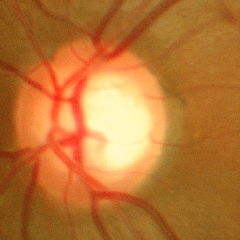 Optic nerve head appearance consistent with no evidence of glaucoma.